2352 by 1568 pixels. FOV: 45 degrees. Color fundus photograph — 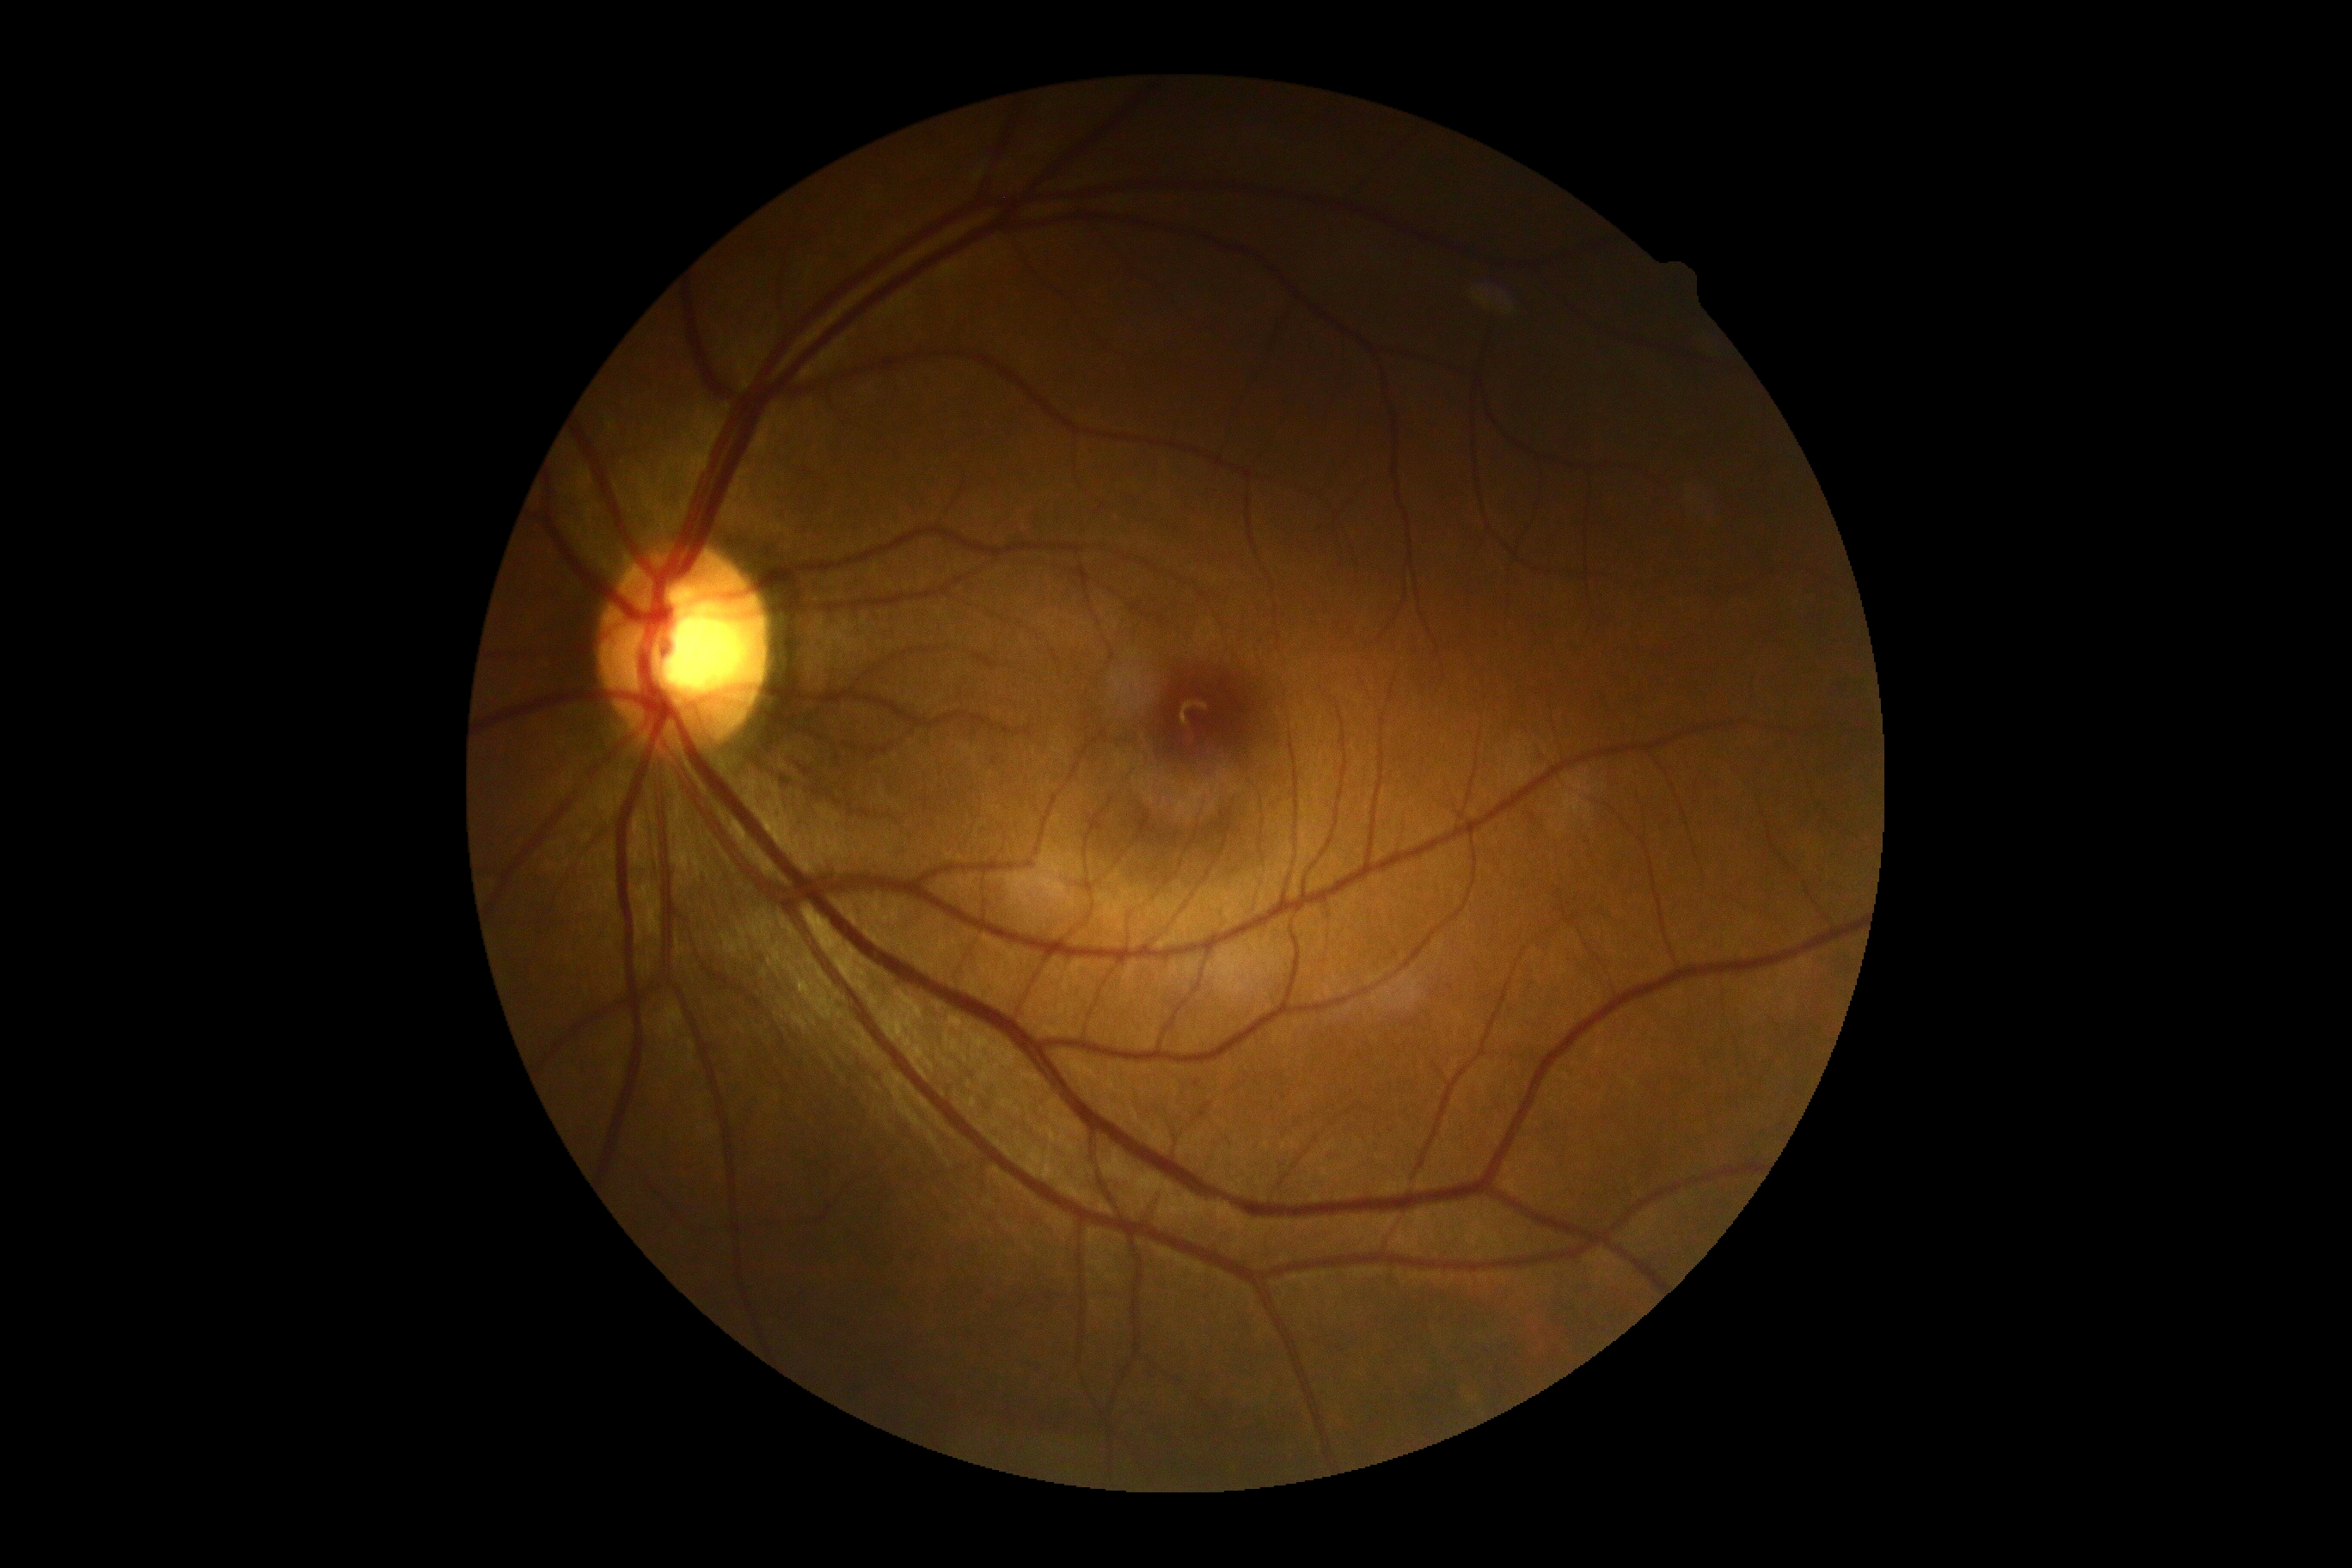
No diabetic retinal disease findings. DR grade is 0 (no apparent retinopathy) — no visible signs of diabetic retinopathy.